Posterior pole color fundus photograph. 848x848.
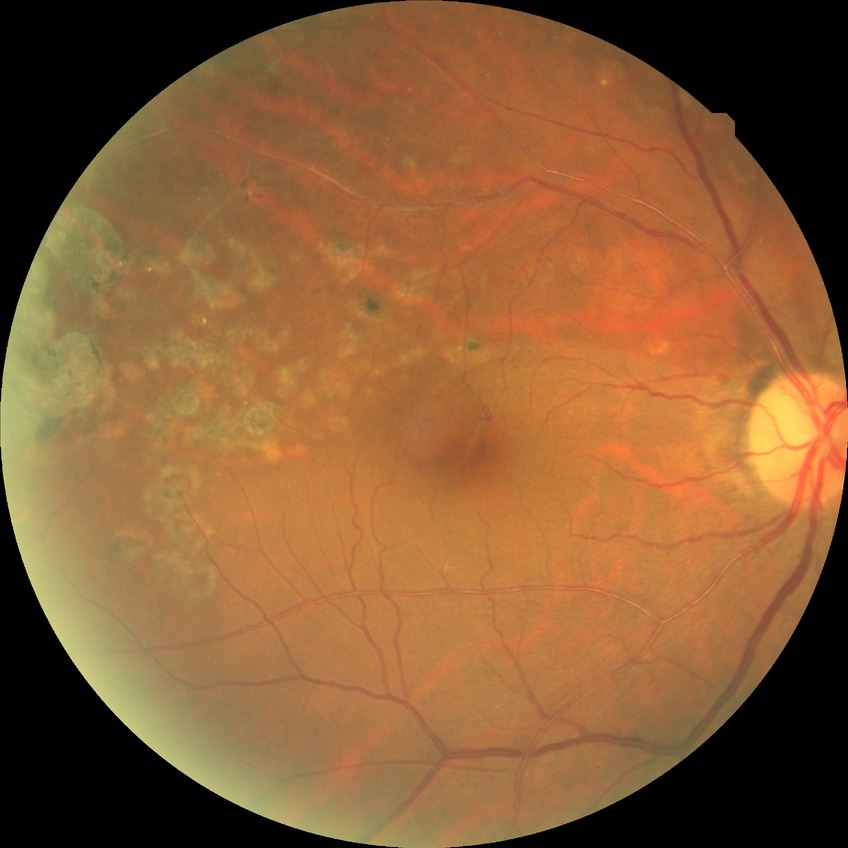

Annotations:
– diabetic retinopathy (DR) — no diabetic retinopathy (NDR)